Infant wide-field fundus photograph · captured with the Clarity RetCam 3 (130° field of view) · 640x480px.
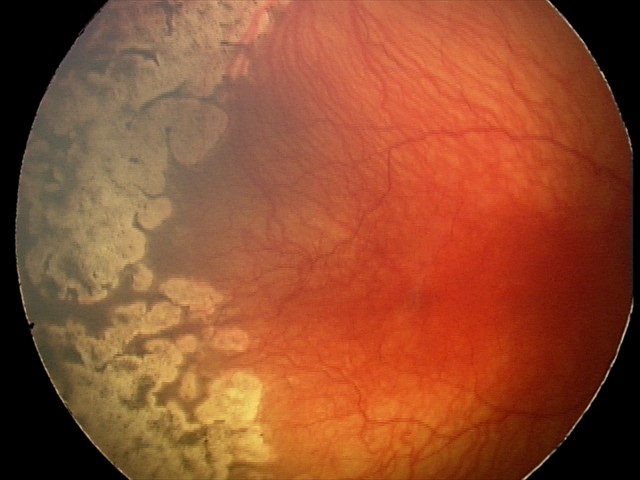
Plus disease: present | diagnosis: aggressive retinopathy of prematurity (A-ROP).